FOV: 45 degrees · fundus photo.
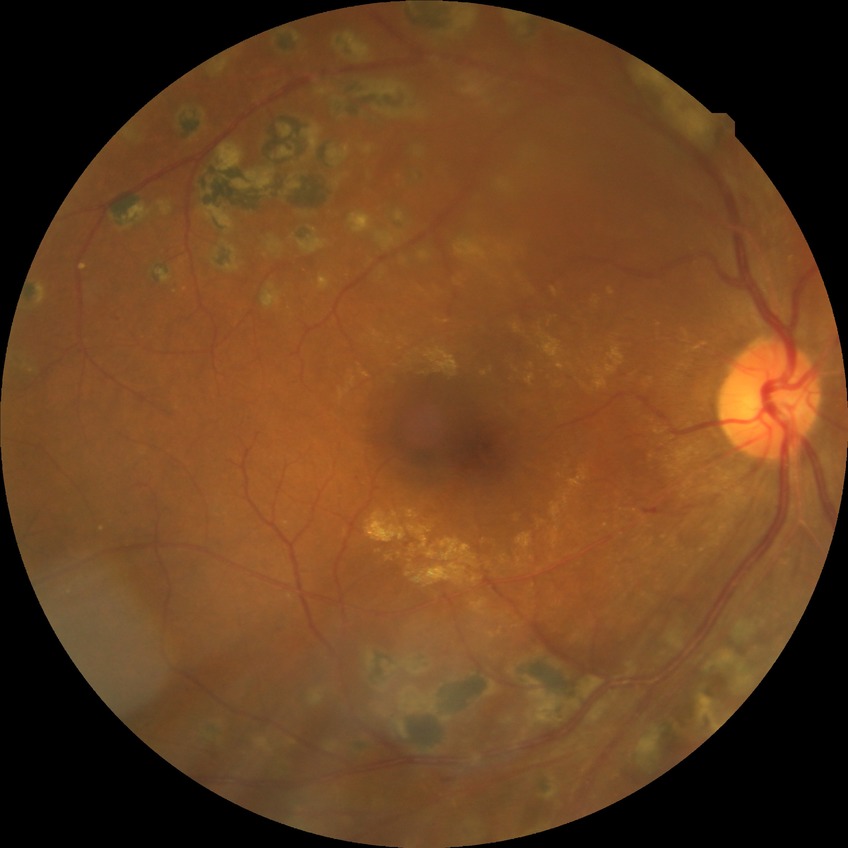 Diabetic retinopathy (DR) is PDR (proliferative diabetic retinopathy).